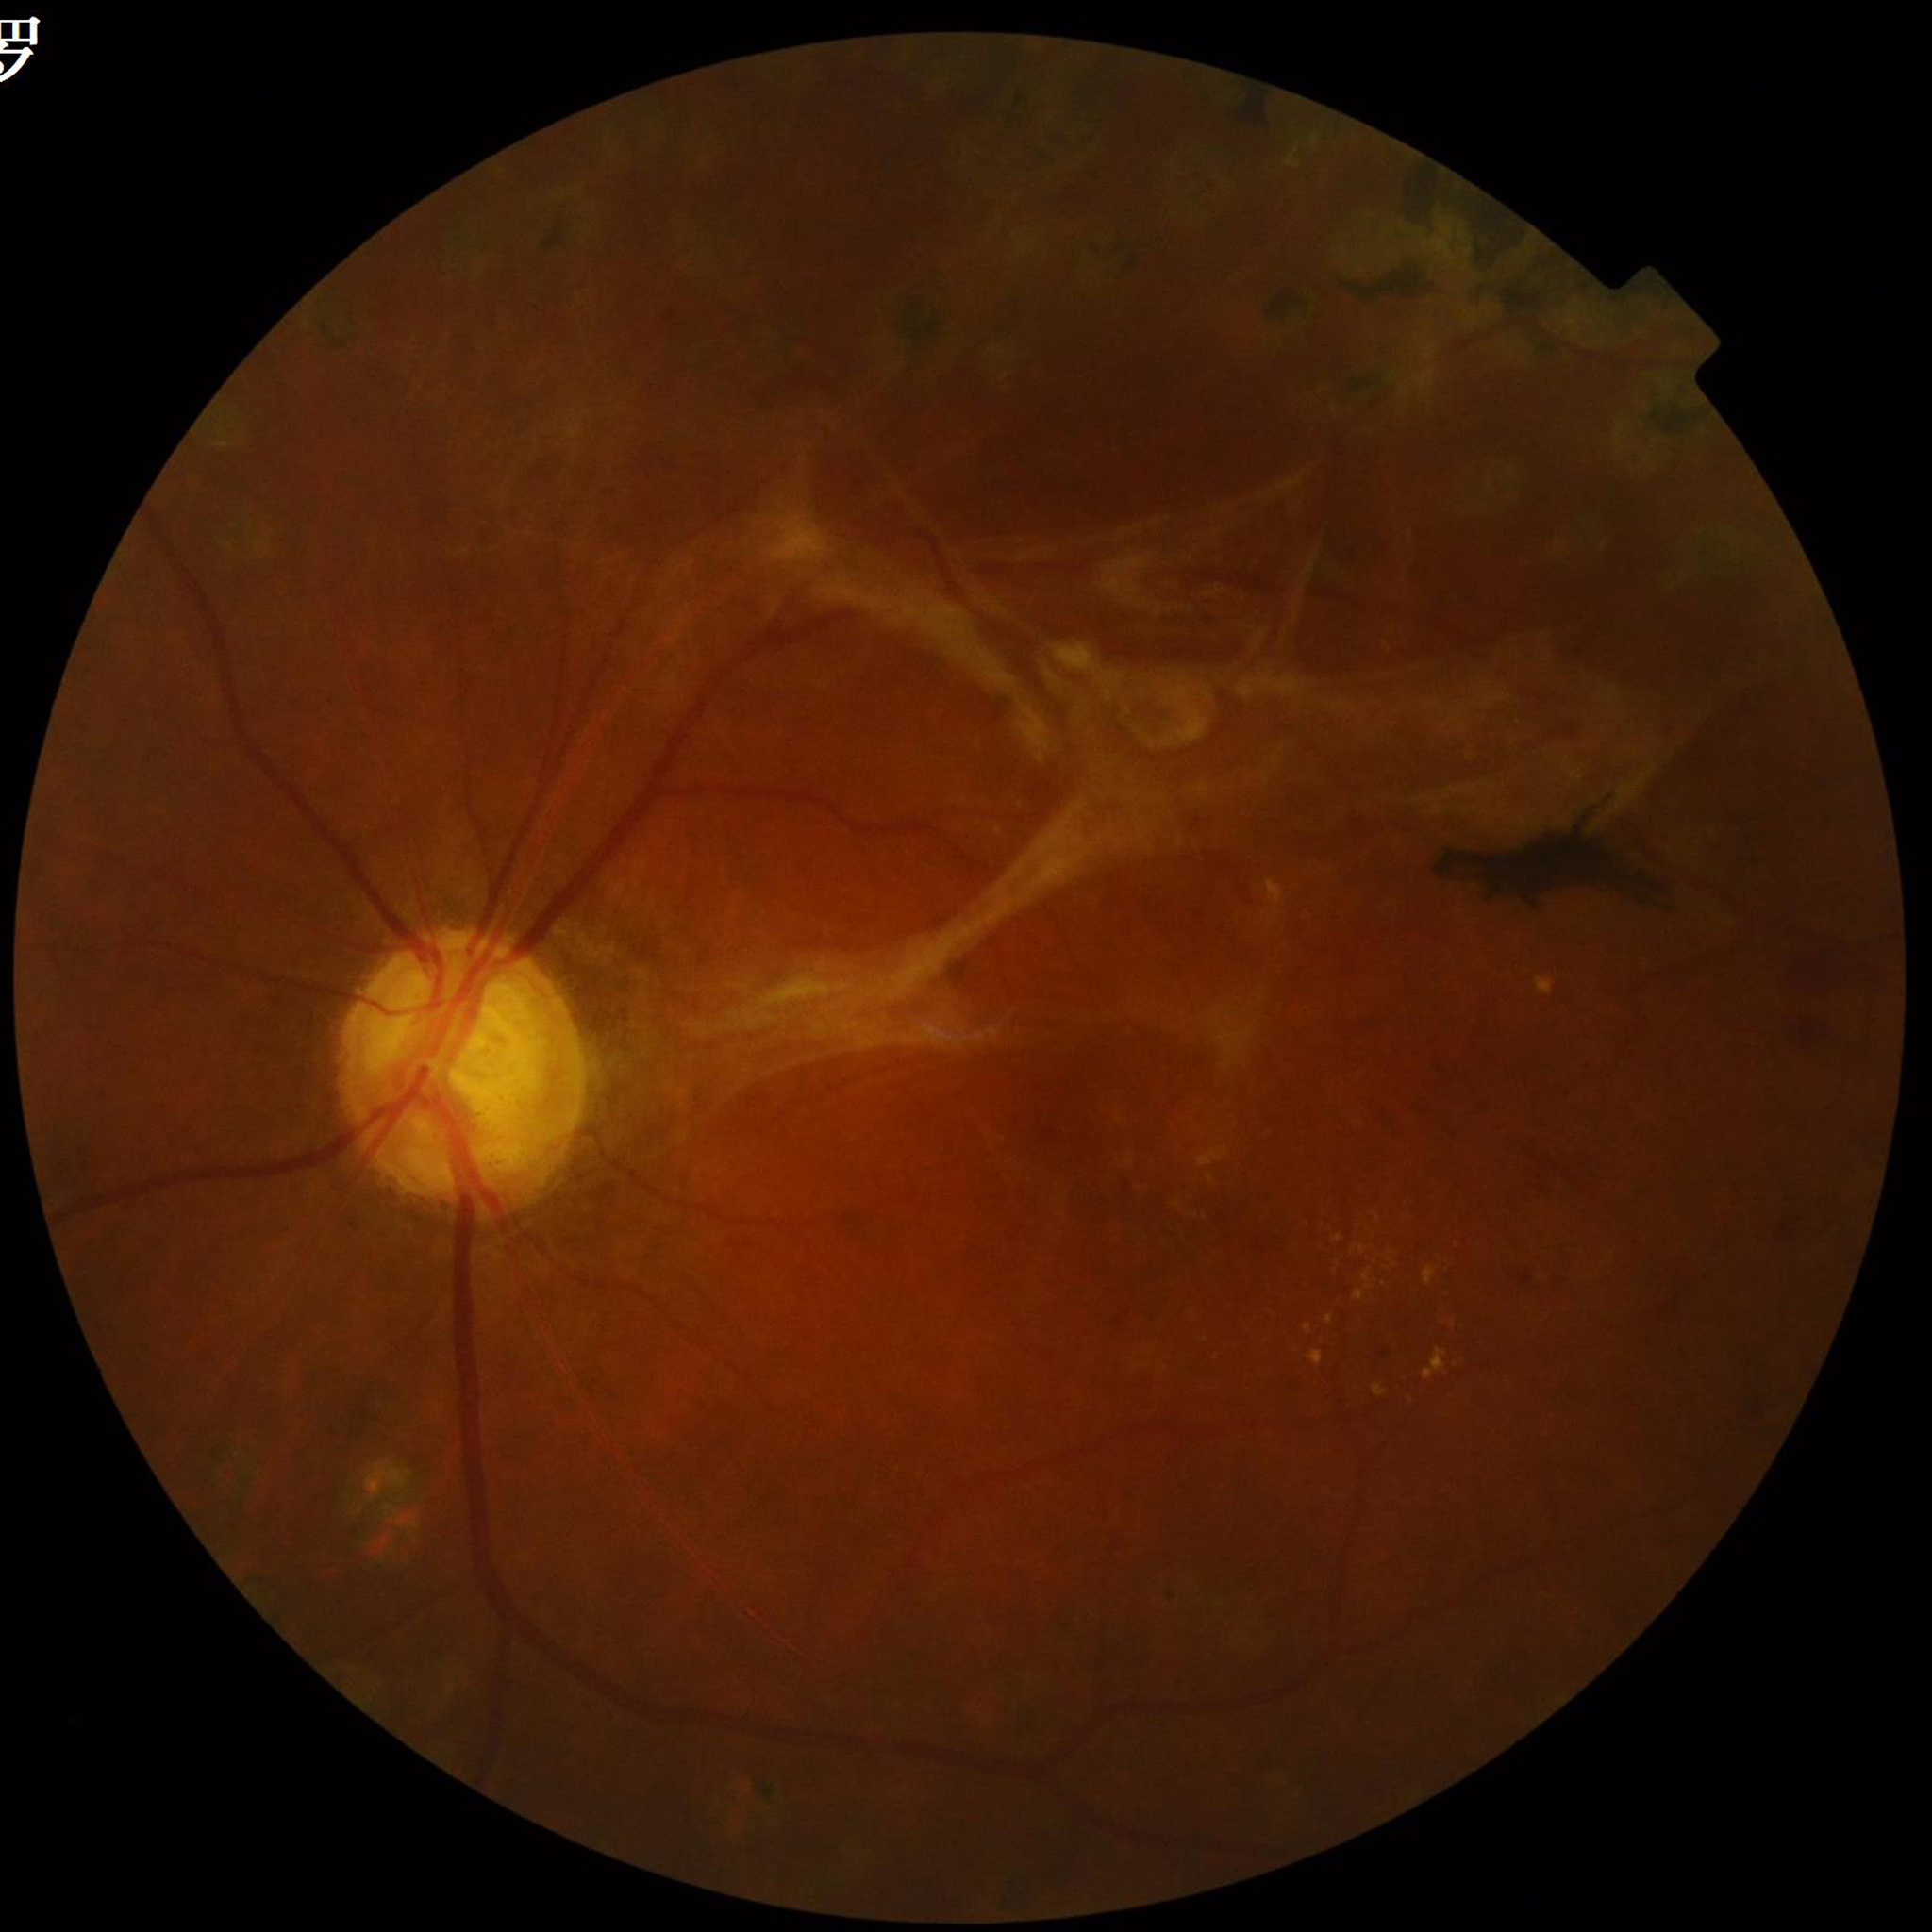

{
  "diagnosis": "diabetic retinopathy"
}